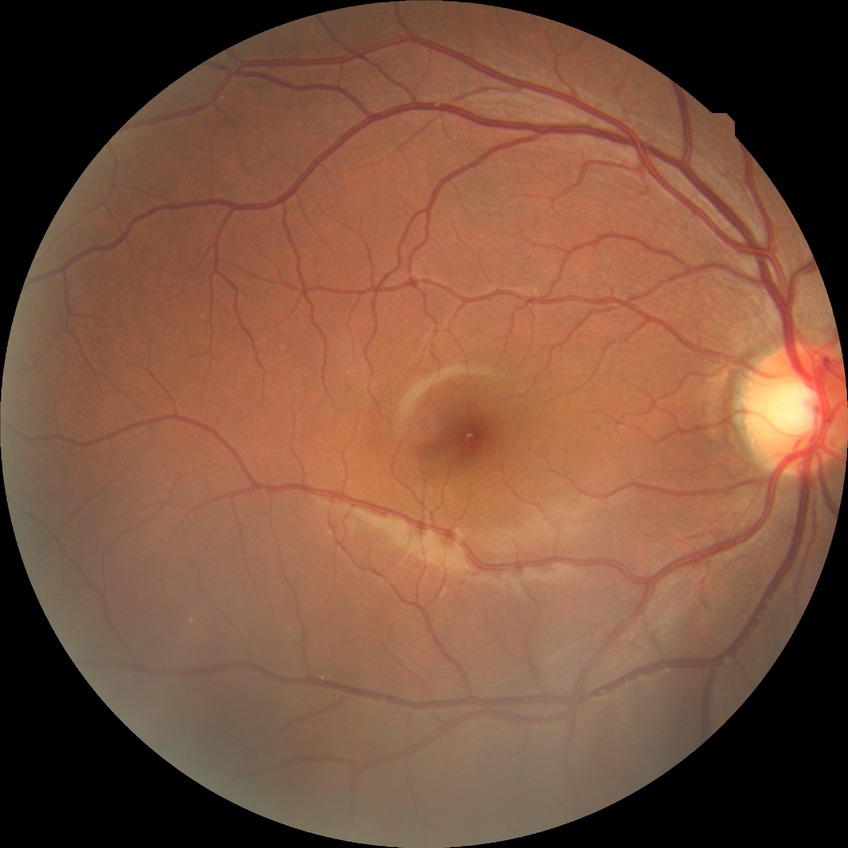 Diabetic retinopathy severity is no diabetic retinopathy.